Diabetic retinopathy graded by the modified Davis classification. Image size 848x848
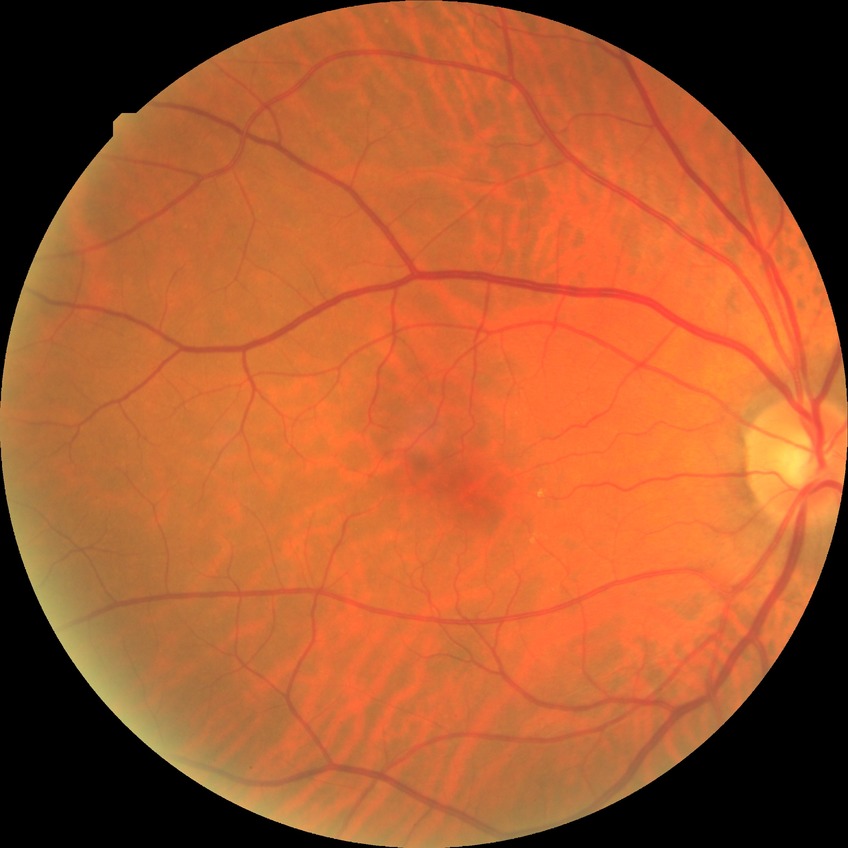

Diabetic retinopathy grade: simple diabetic retinopathy.